Color fundus image; 848x848:
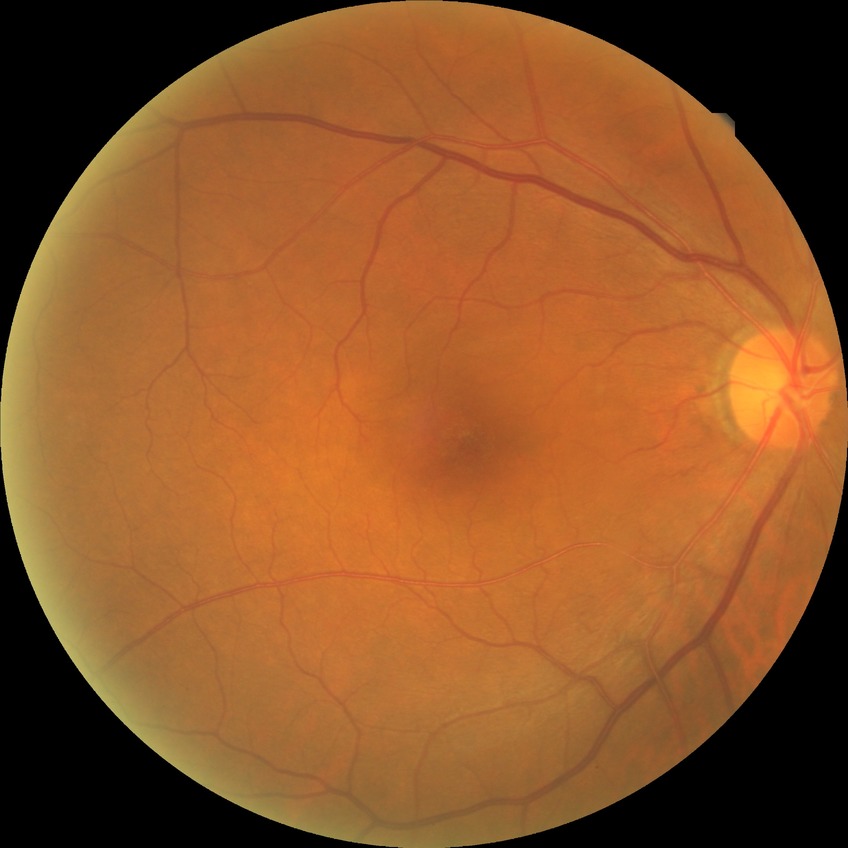 Retinopathy grade is simple diabetic retinopathy.